Color fundus image. Camera: Topcon TRC-NW8. Centered on the macula
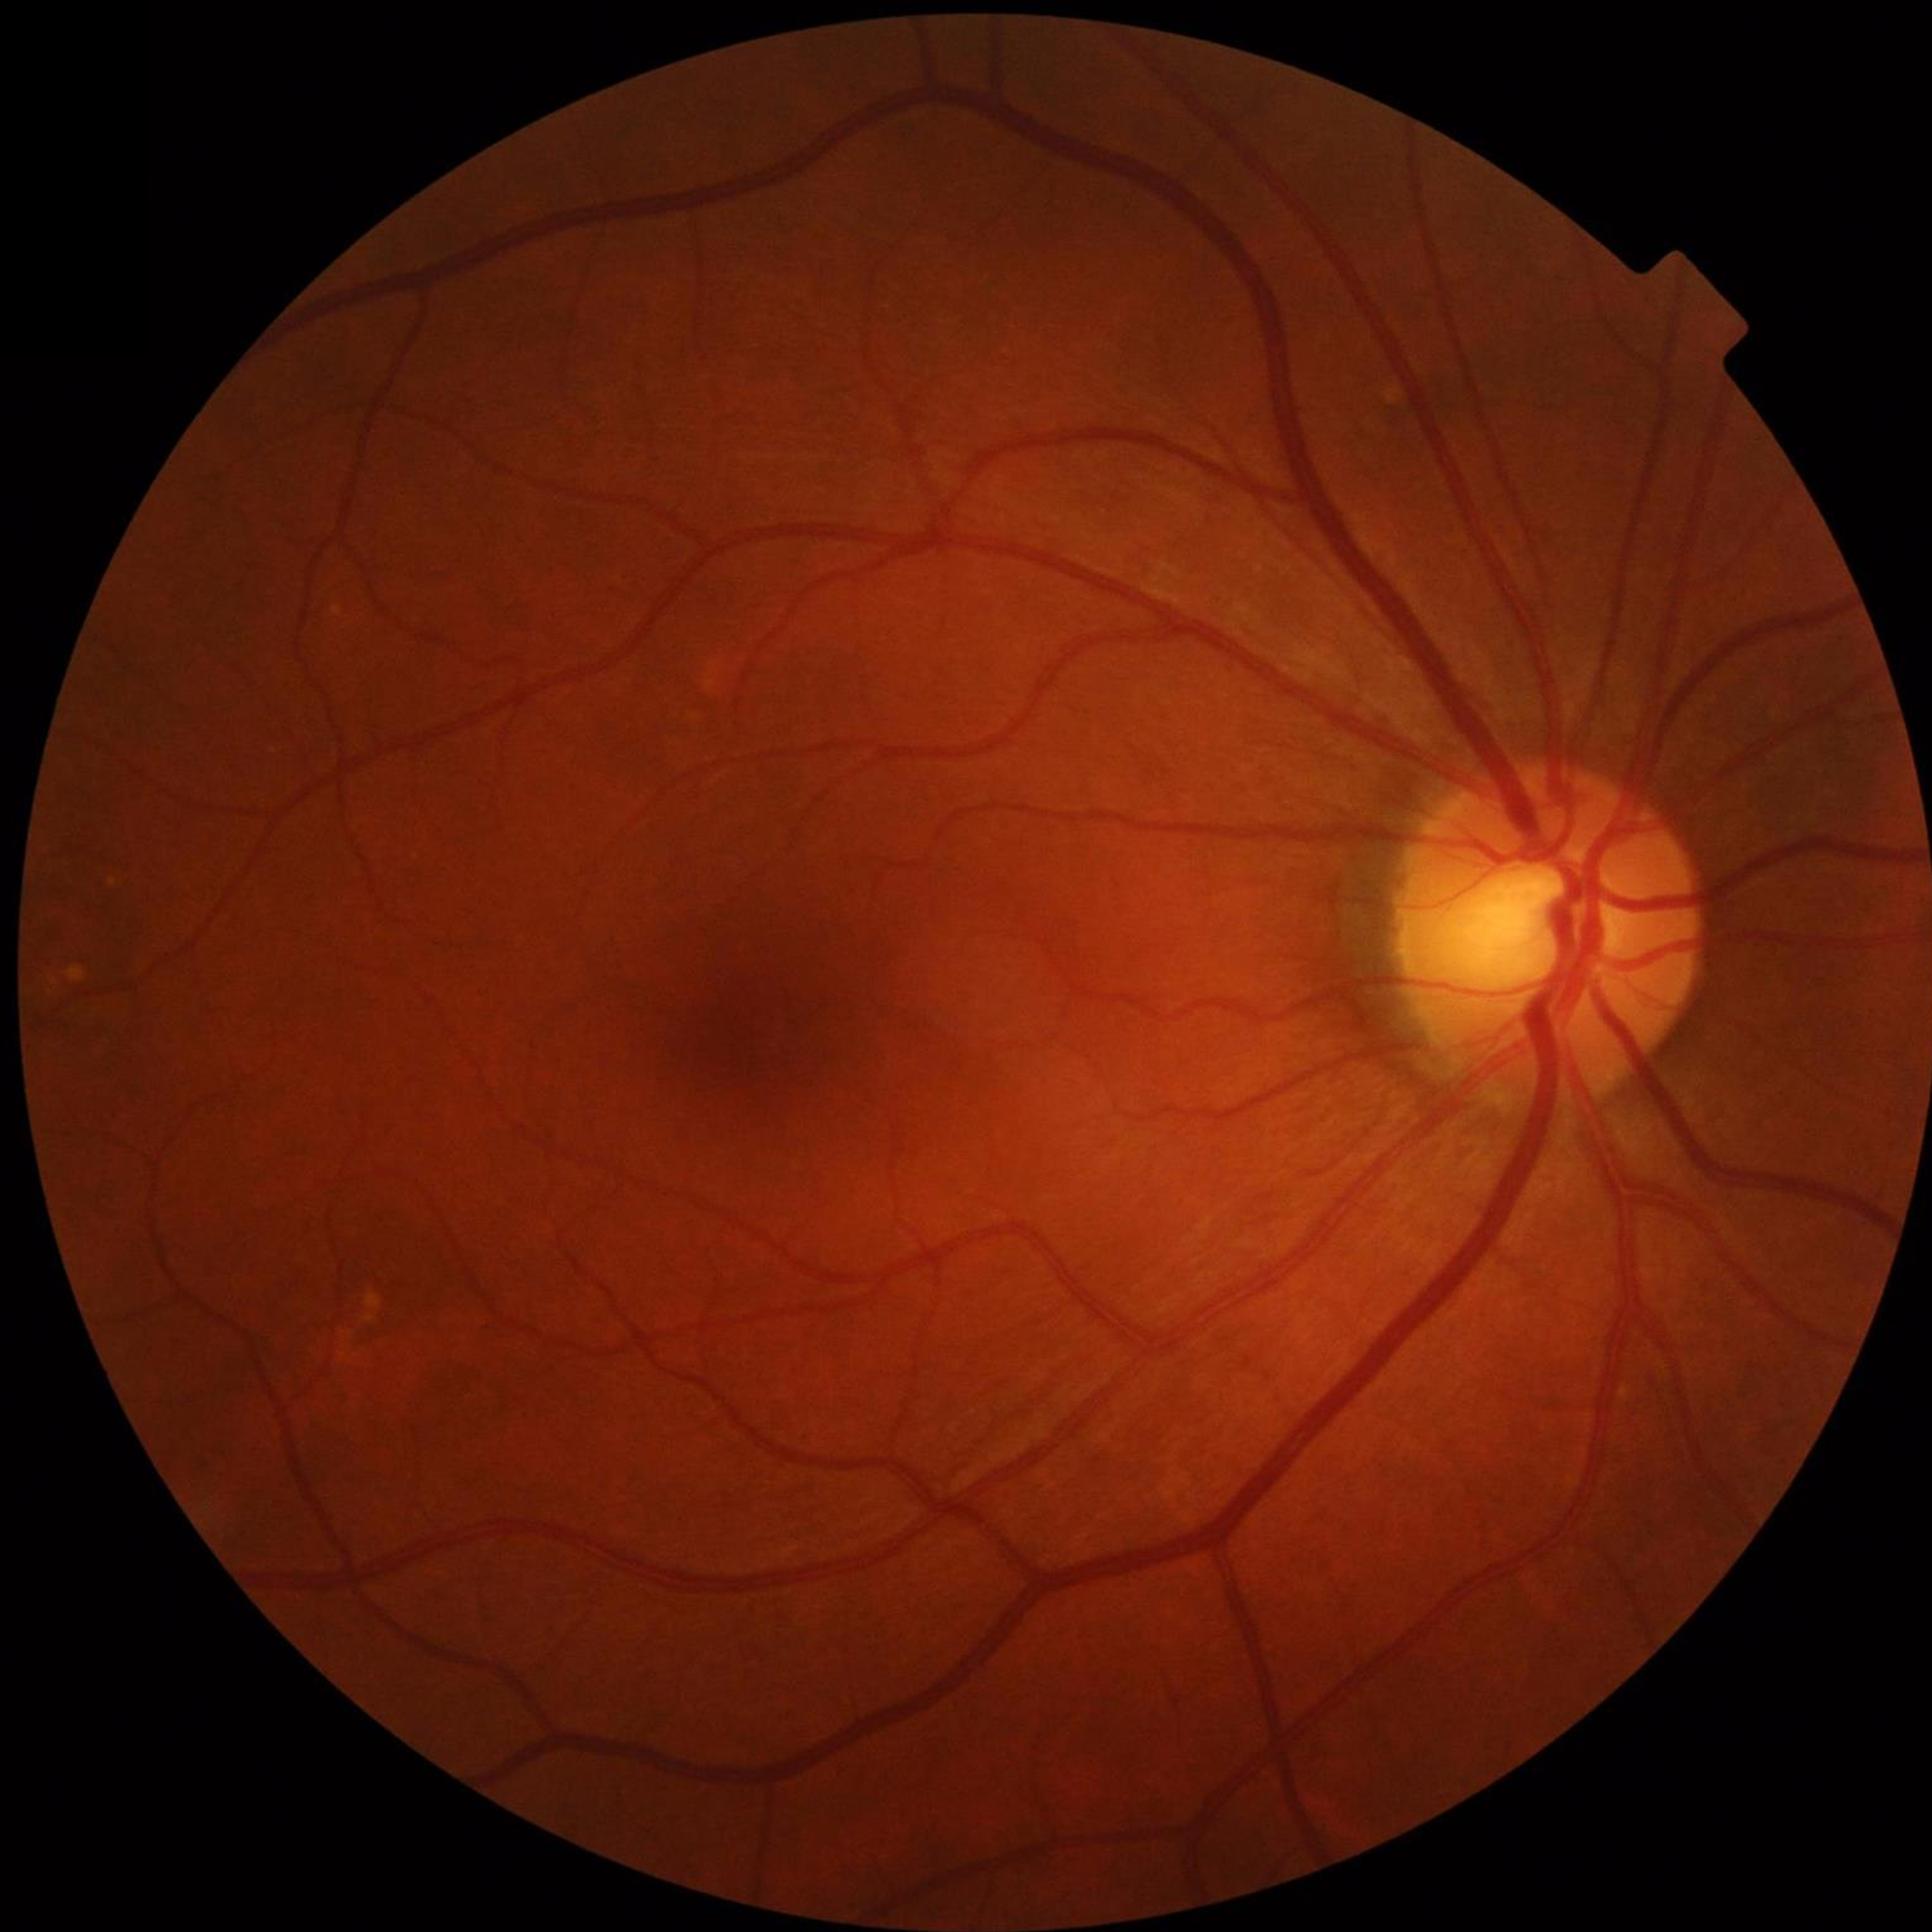 Disease class: no AMD, DR, or glaucoma.